Tabletop color fundus camera image.
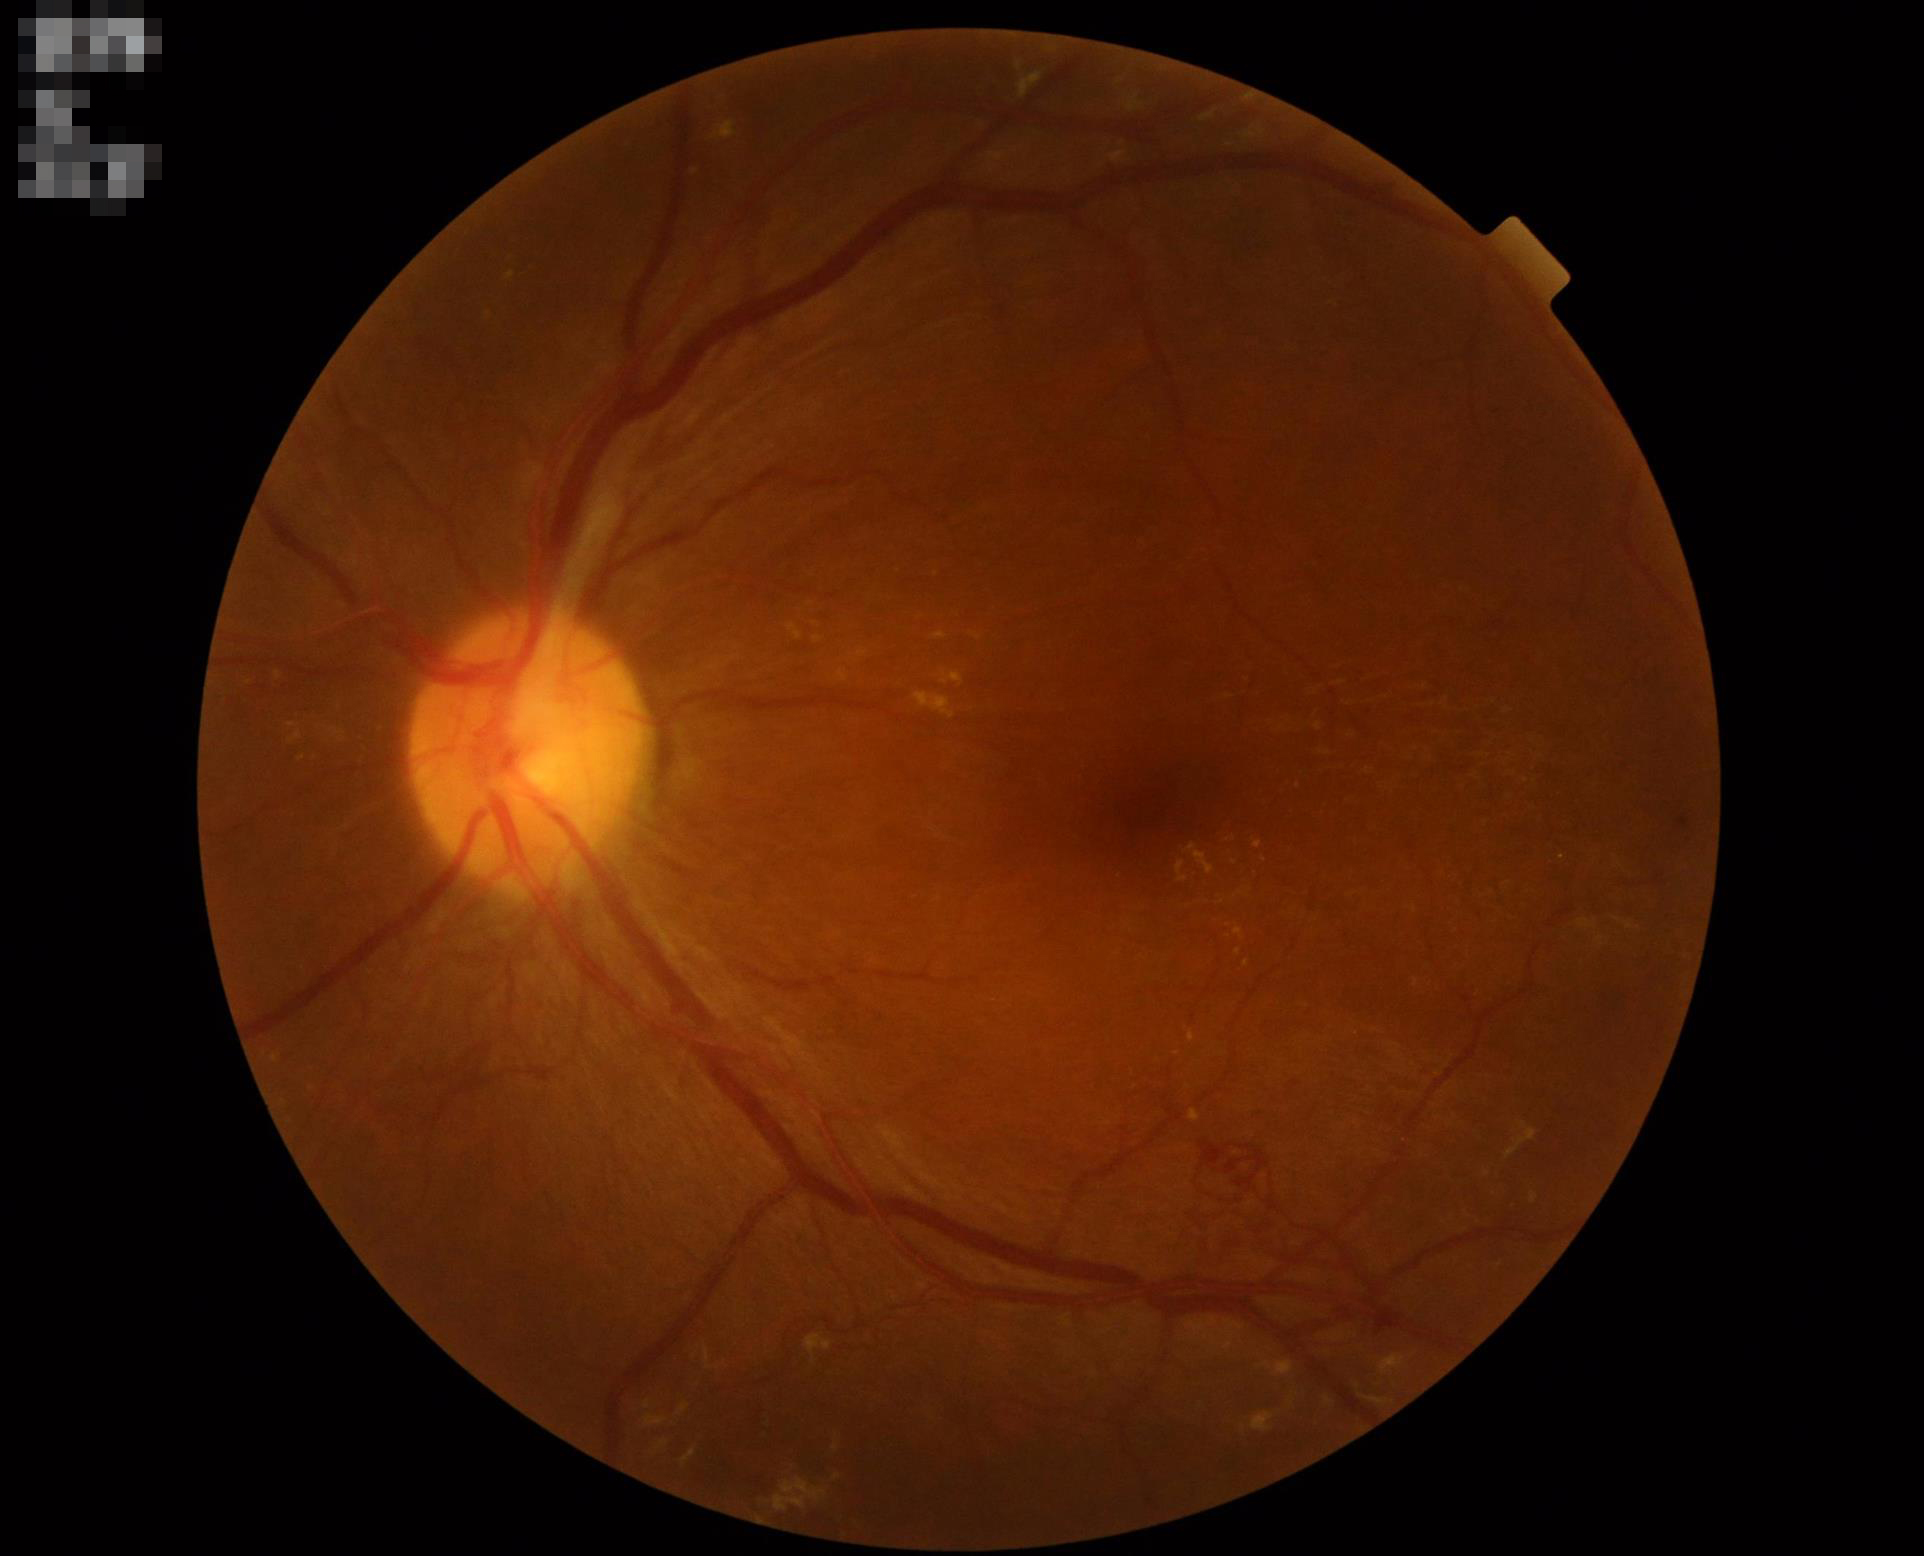 Focus: in focus | Illumination: good | Contrast: adequate.